Modified Davis grading · NIDEK AFC-230 — 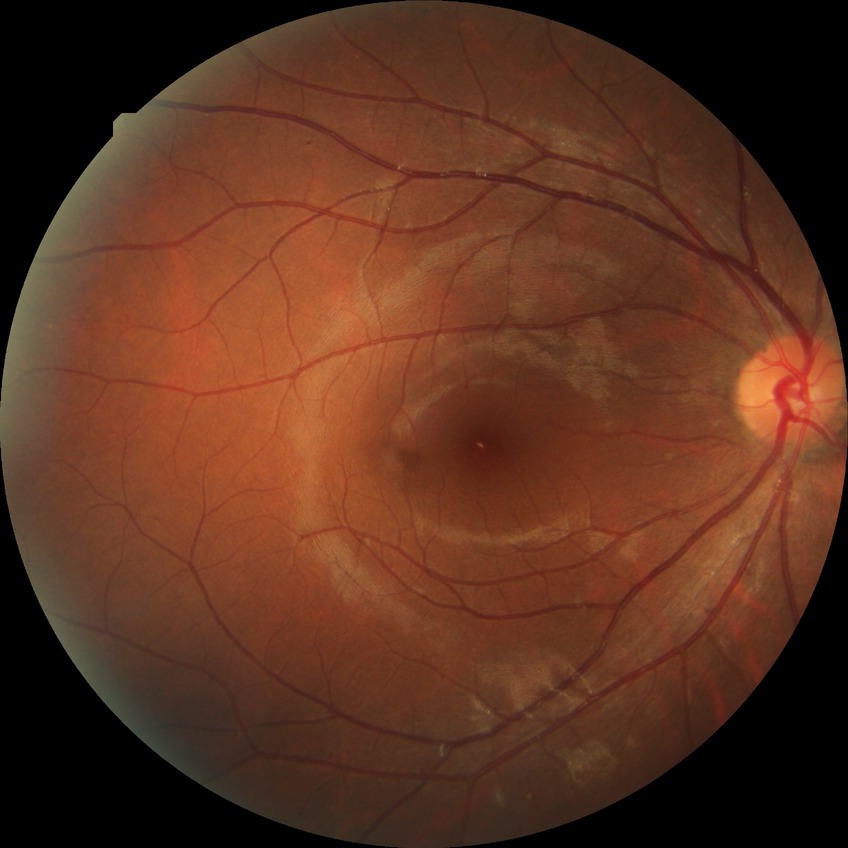
Diabetic retinopathy severity: no diabetic retinopathy.